848 x 848 pixels · nonmydriatic · color fundus photograph:
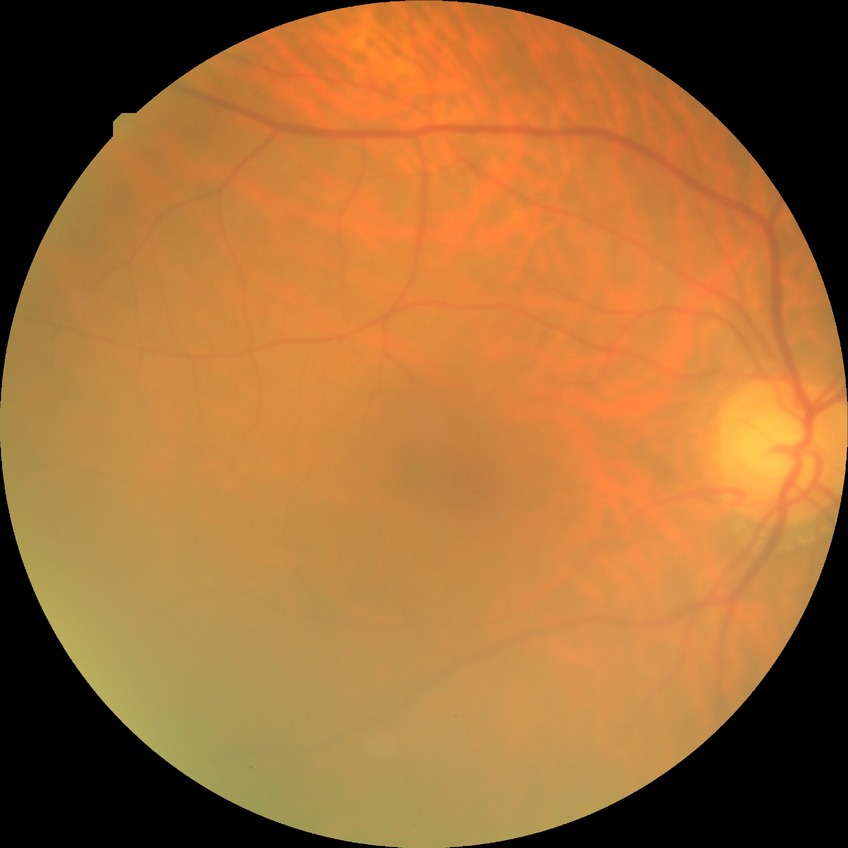

Diabetic retinopathy (DR): no diabetic retinopathy (NDR).